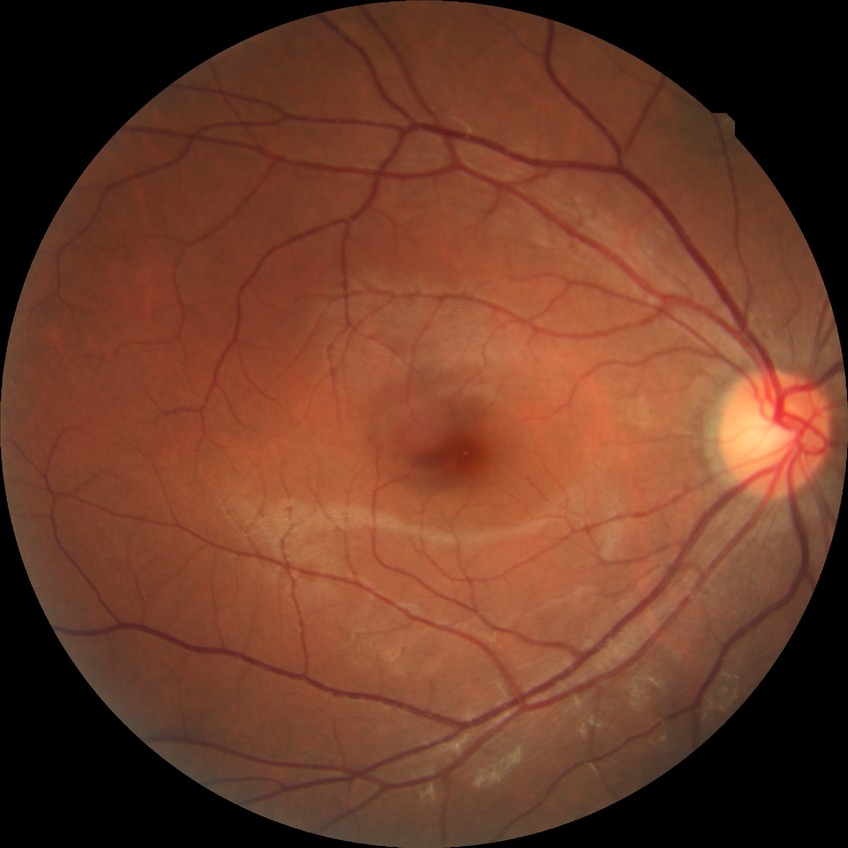

Diabetic retinopathy (DR) is no diabetic retinopathy (NDR).